Acquired with a Nidek AFC-330 · disc-centered field:
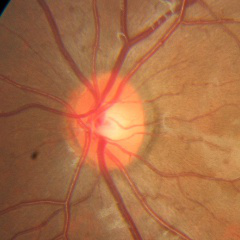

Demonstrates no glaucomatous findings.